1240x1240px · 100° field of view (Phoenix ICON) · wide-field contact fundus photograph of an infant — 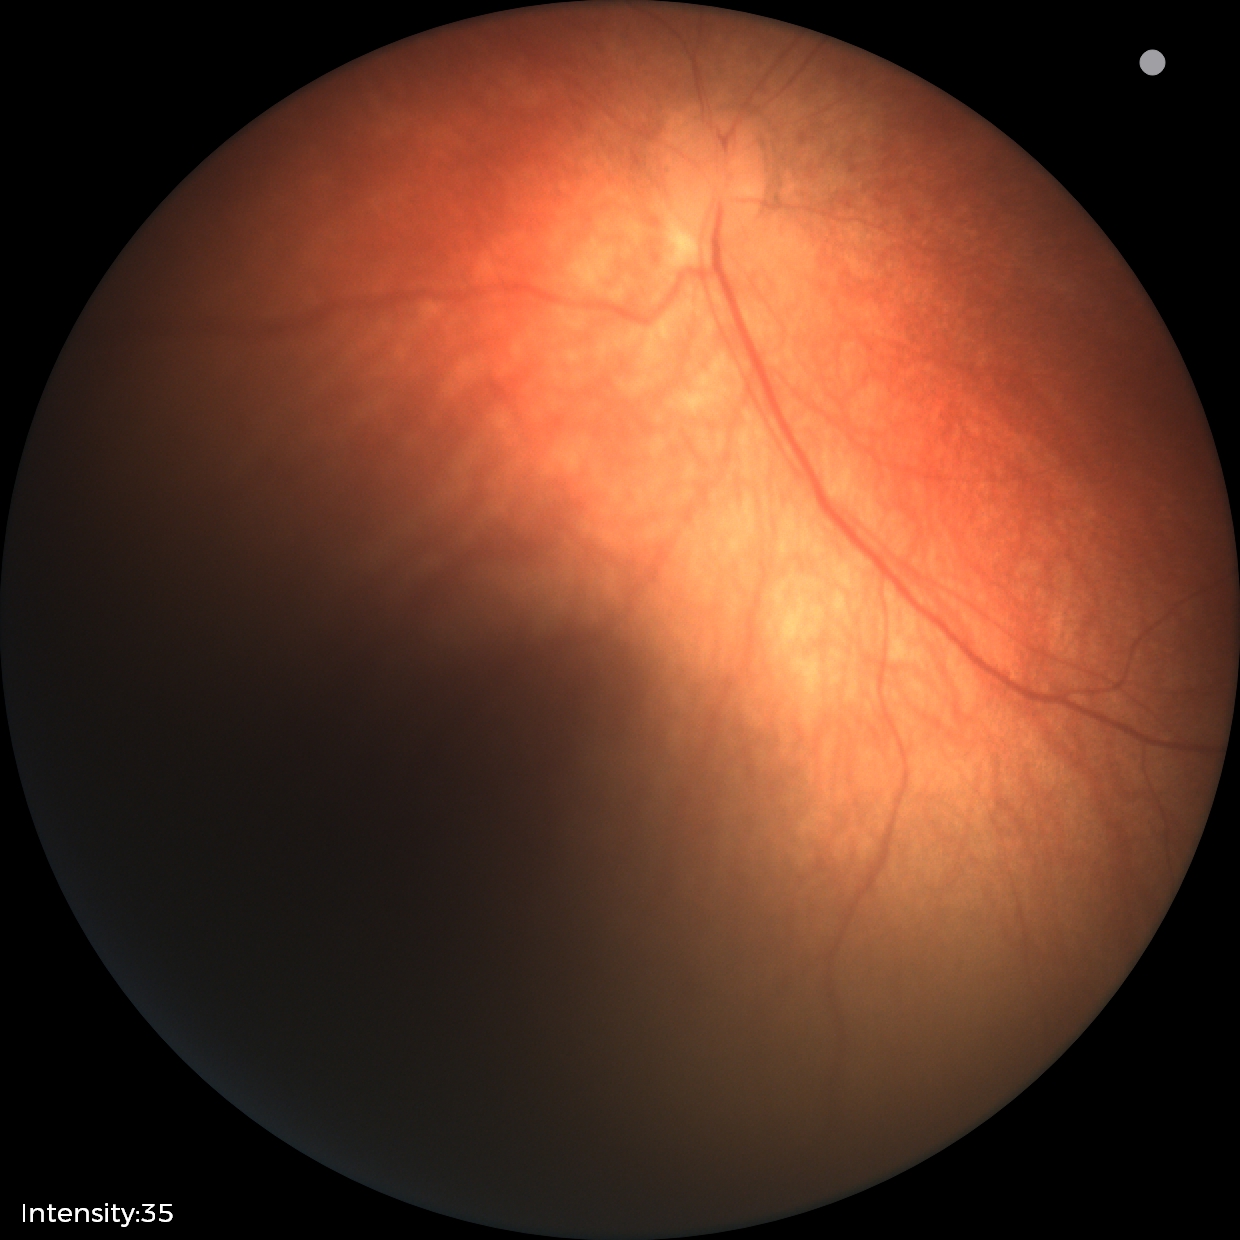
No retinal pathology identified on screening.